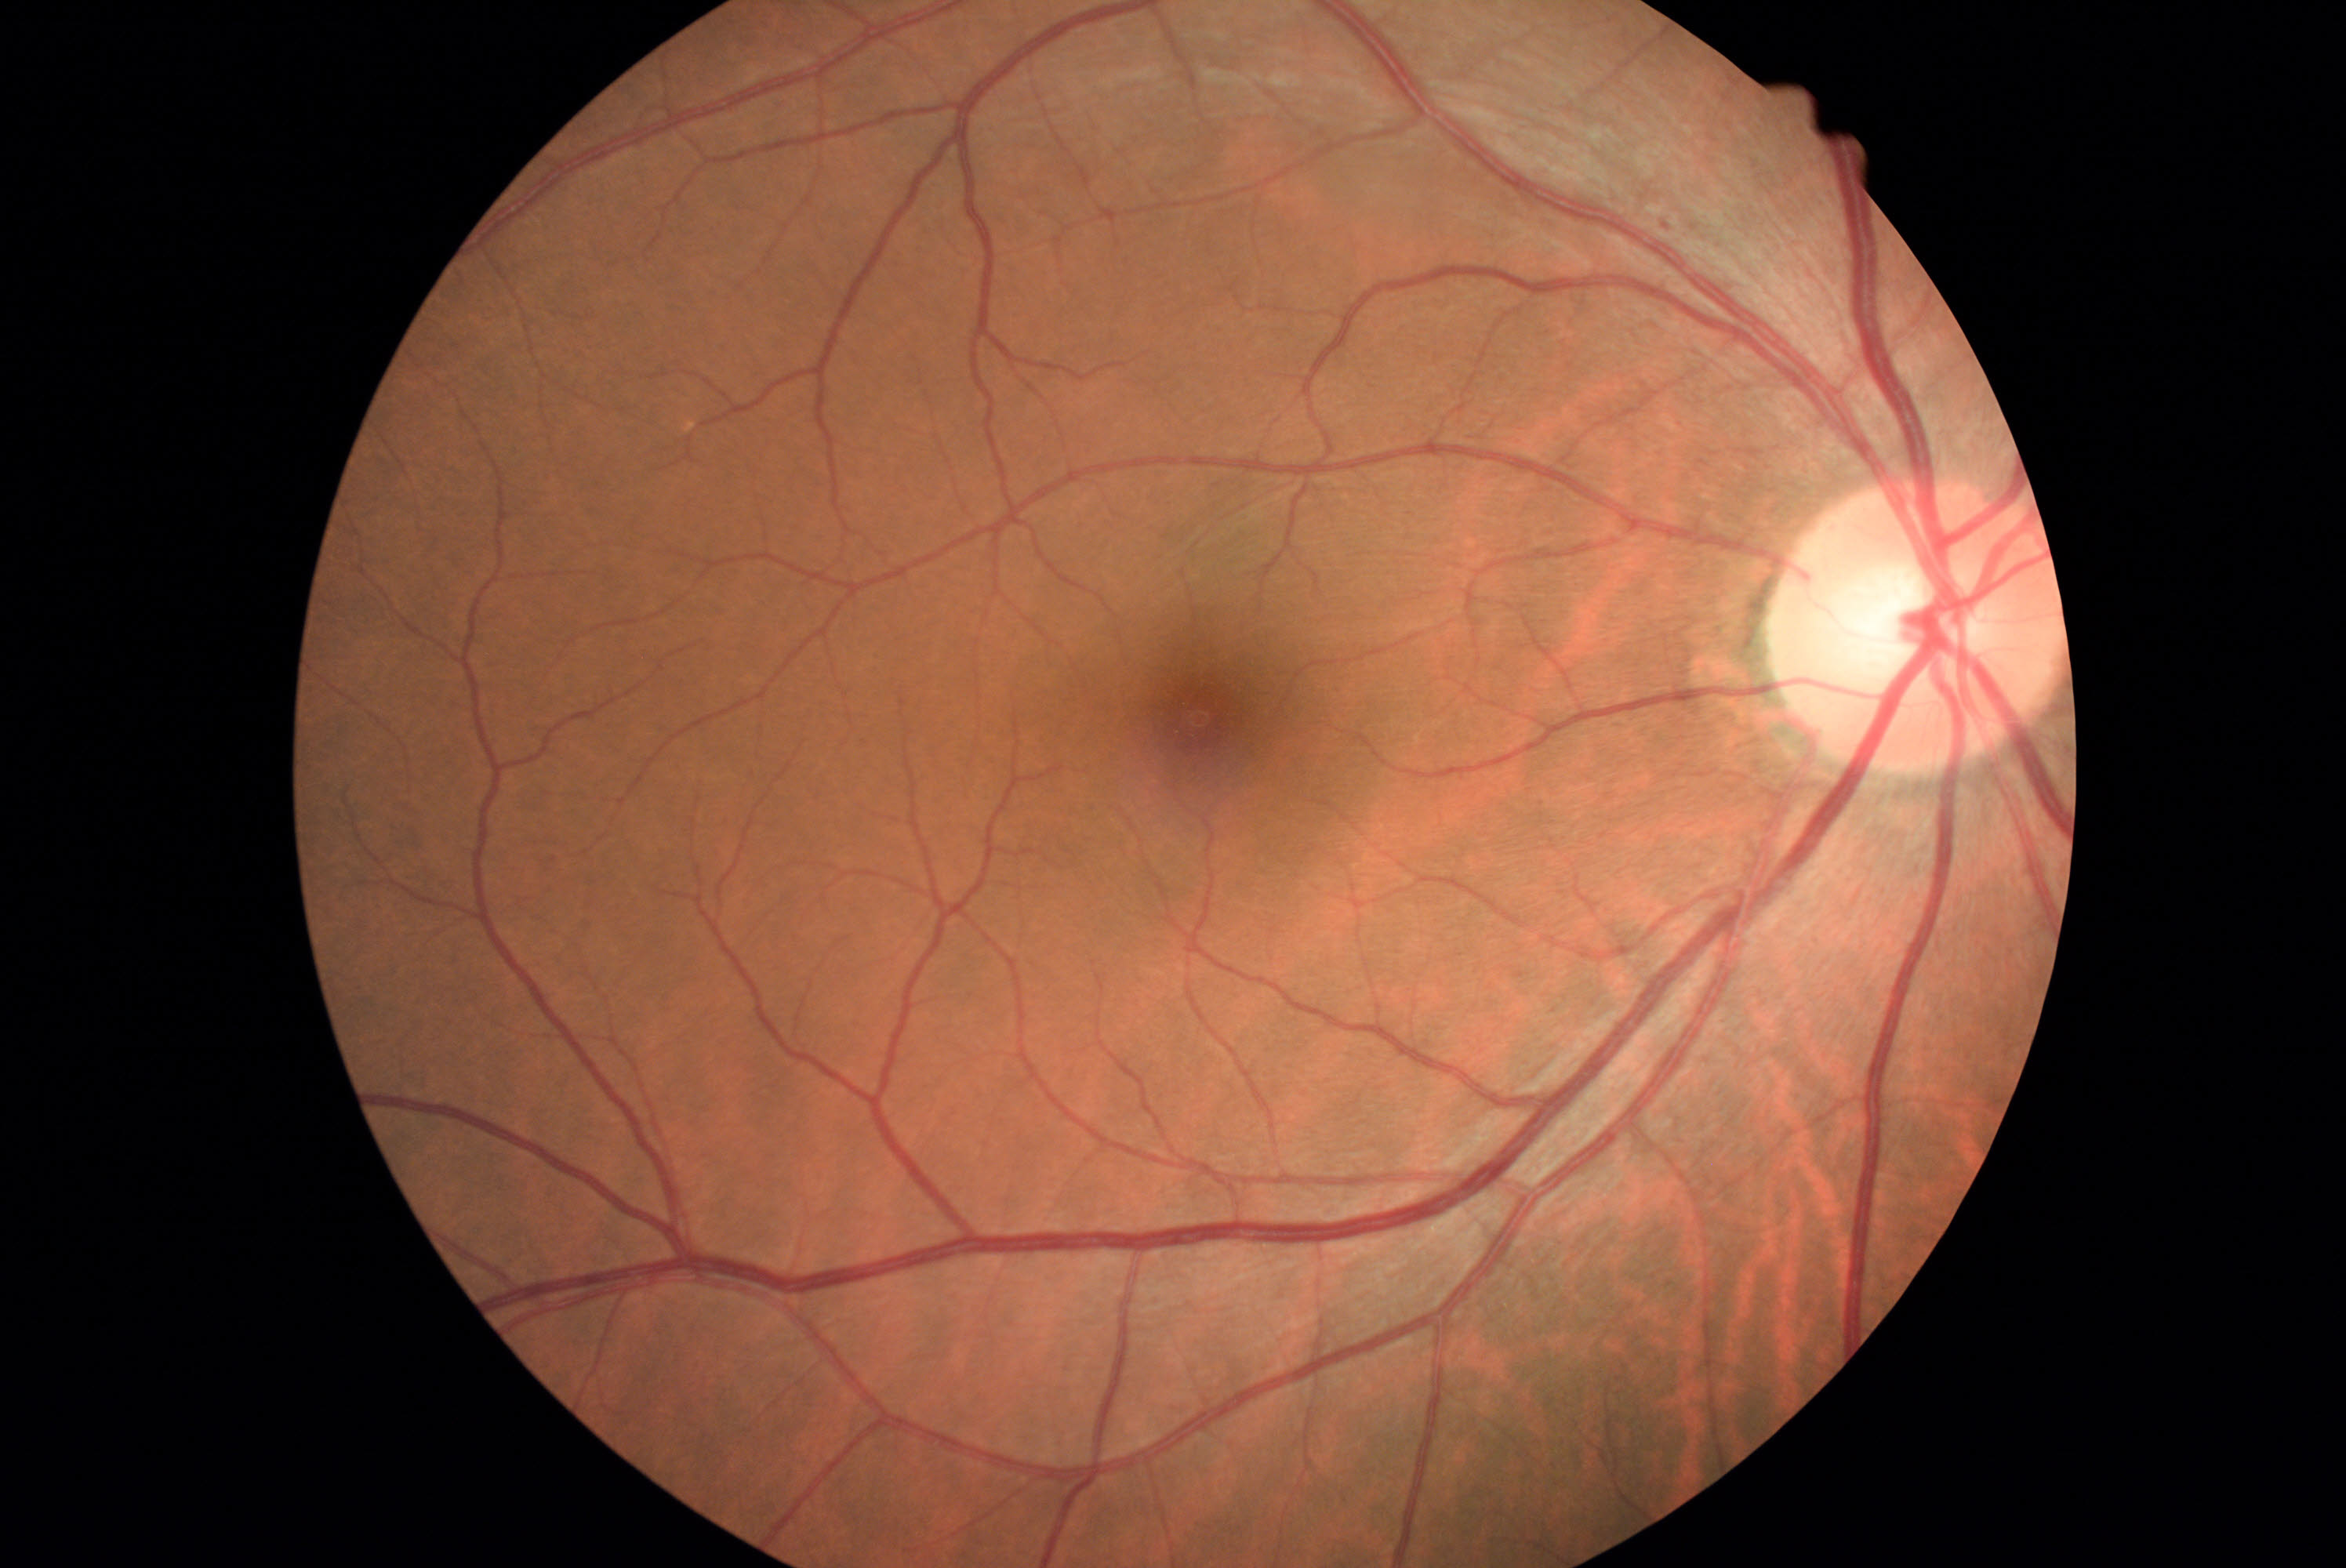
{"dr_grade":1,"lesions":{"se":null,"ma":[[1663,223,1671,231]],"he":null,"ex":null}}